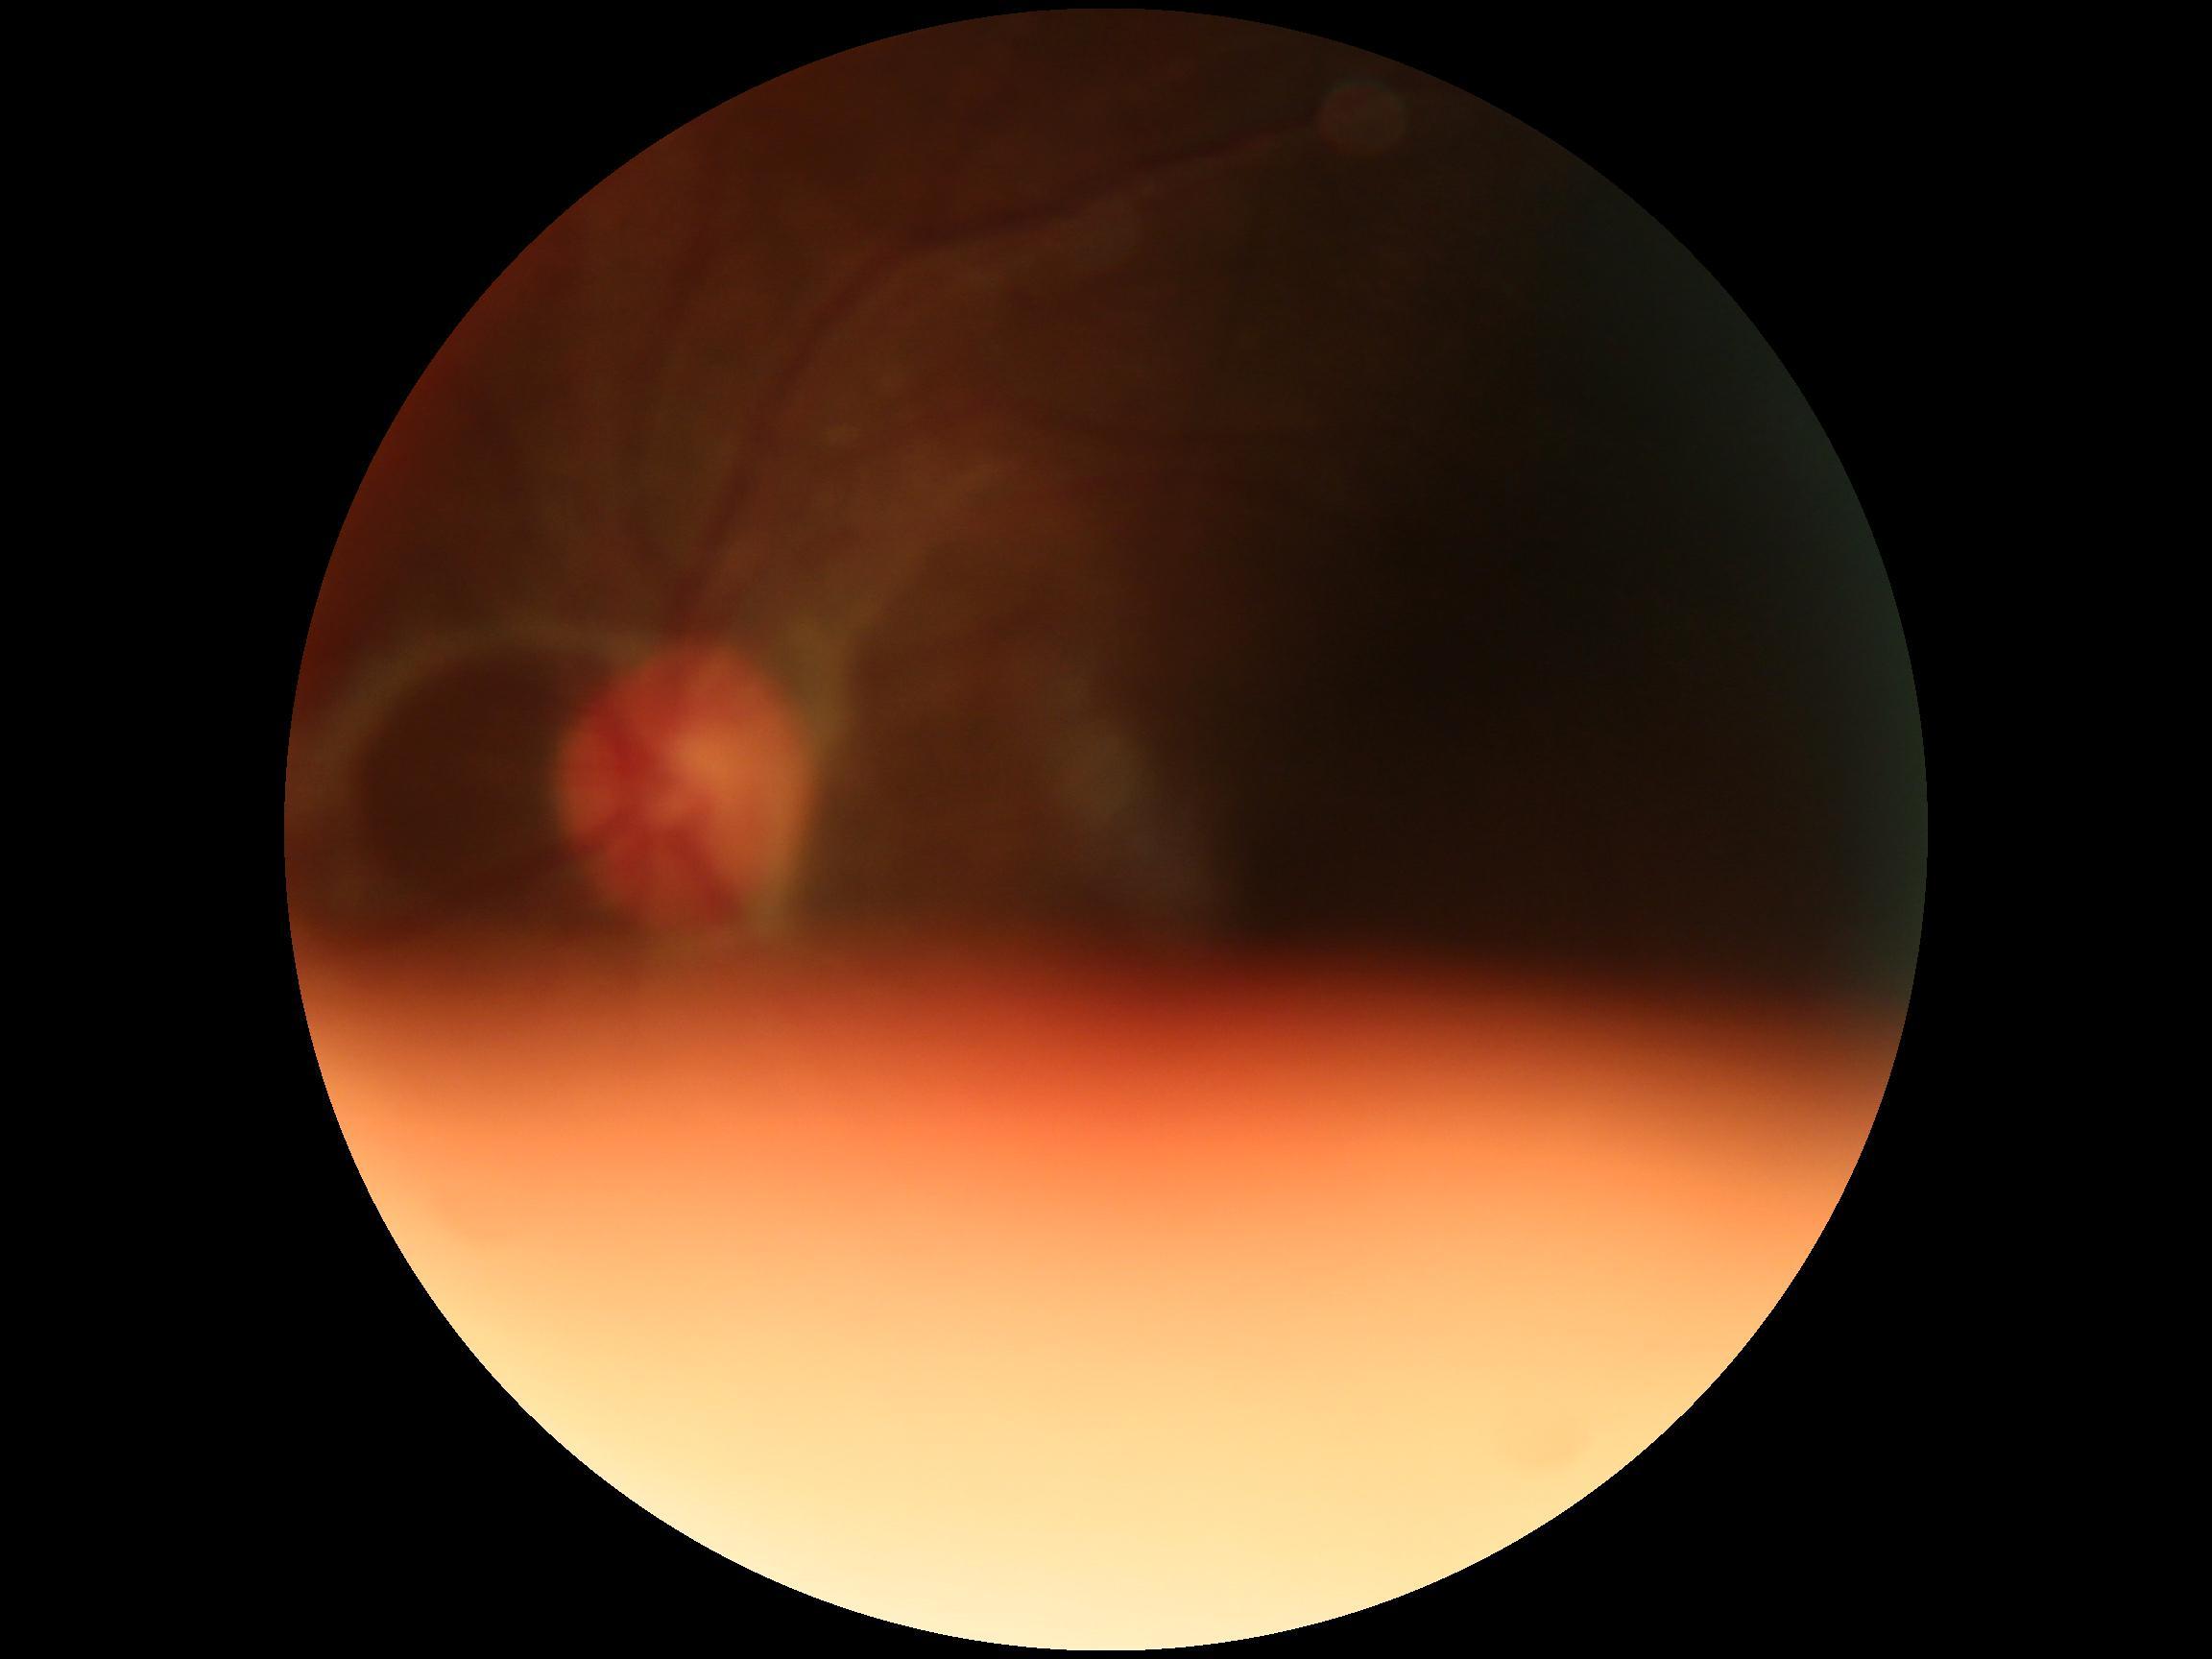 DR stage: ungradable